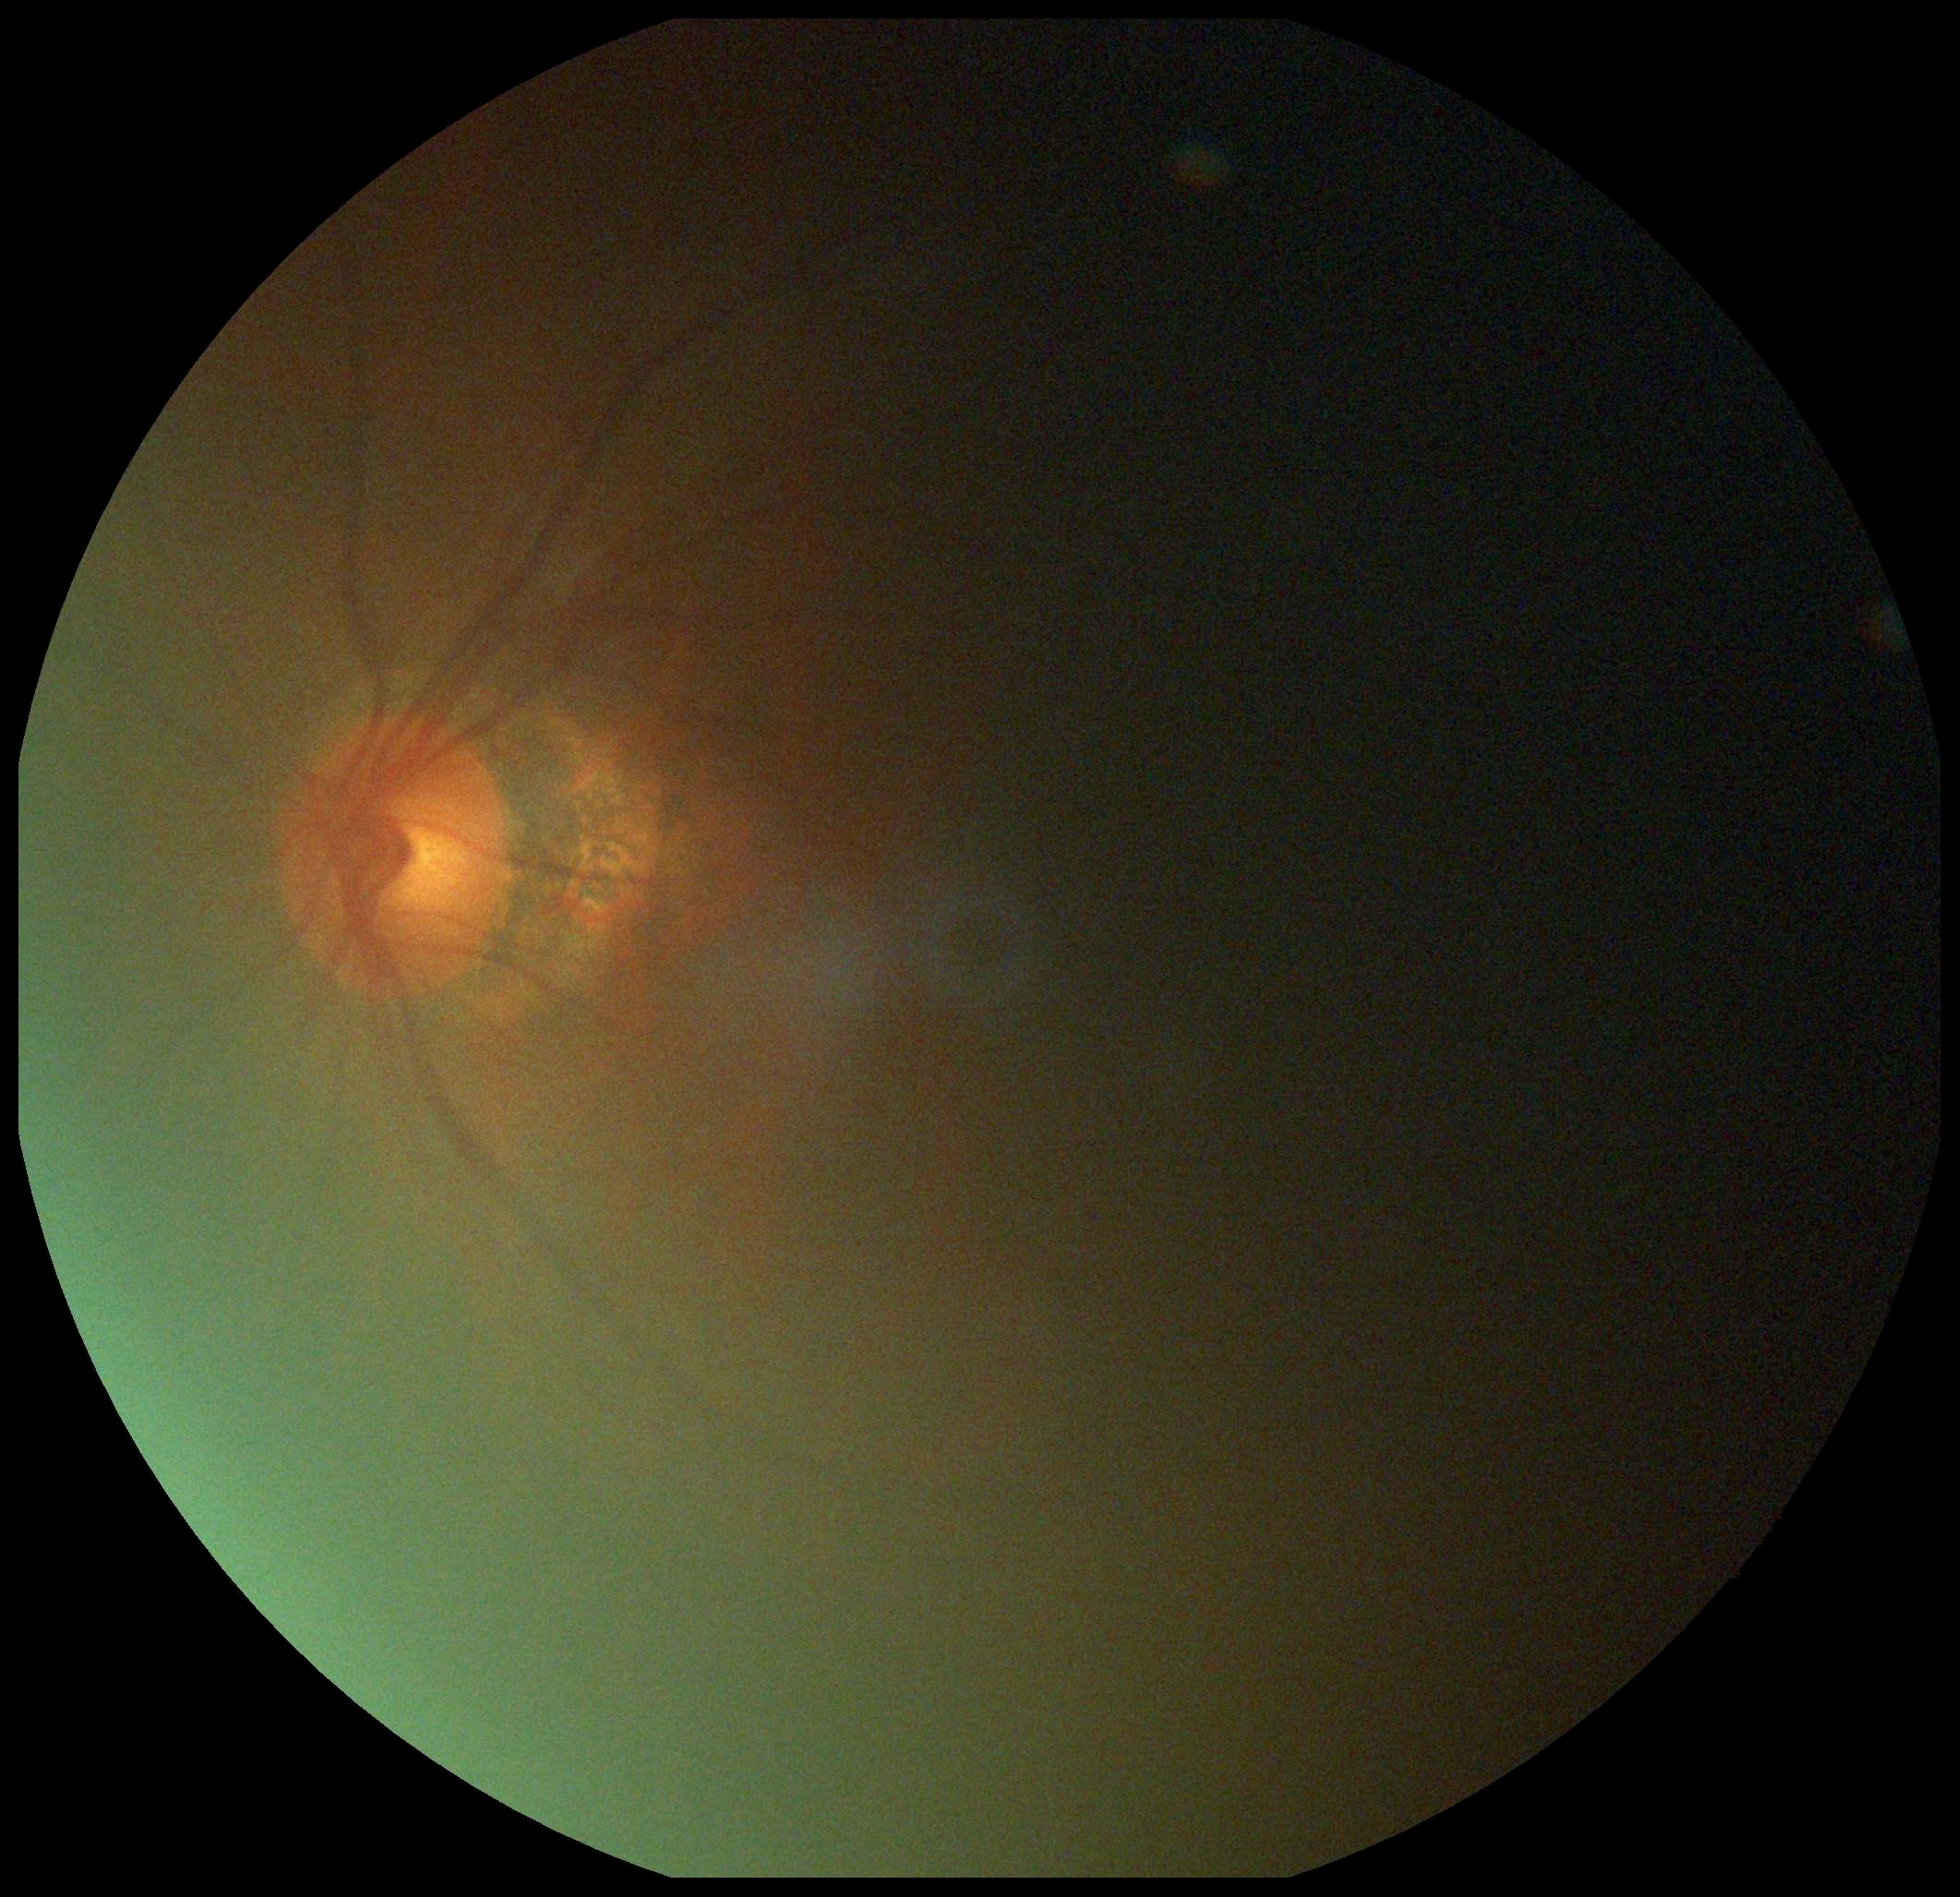
DR: ungradable.